1932x1910: 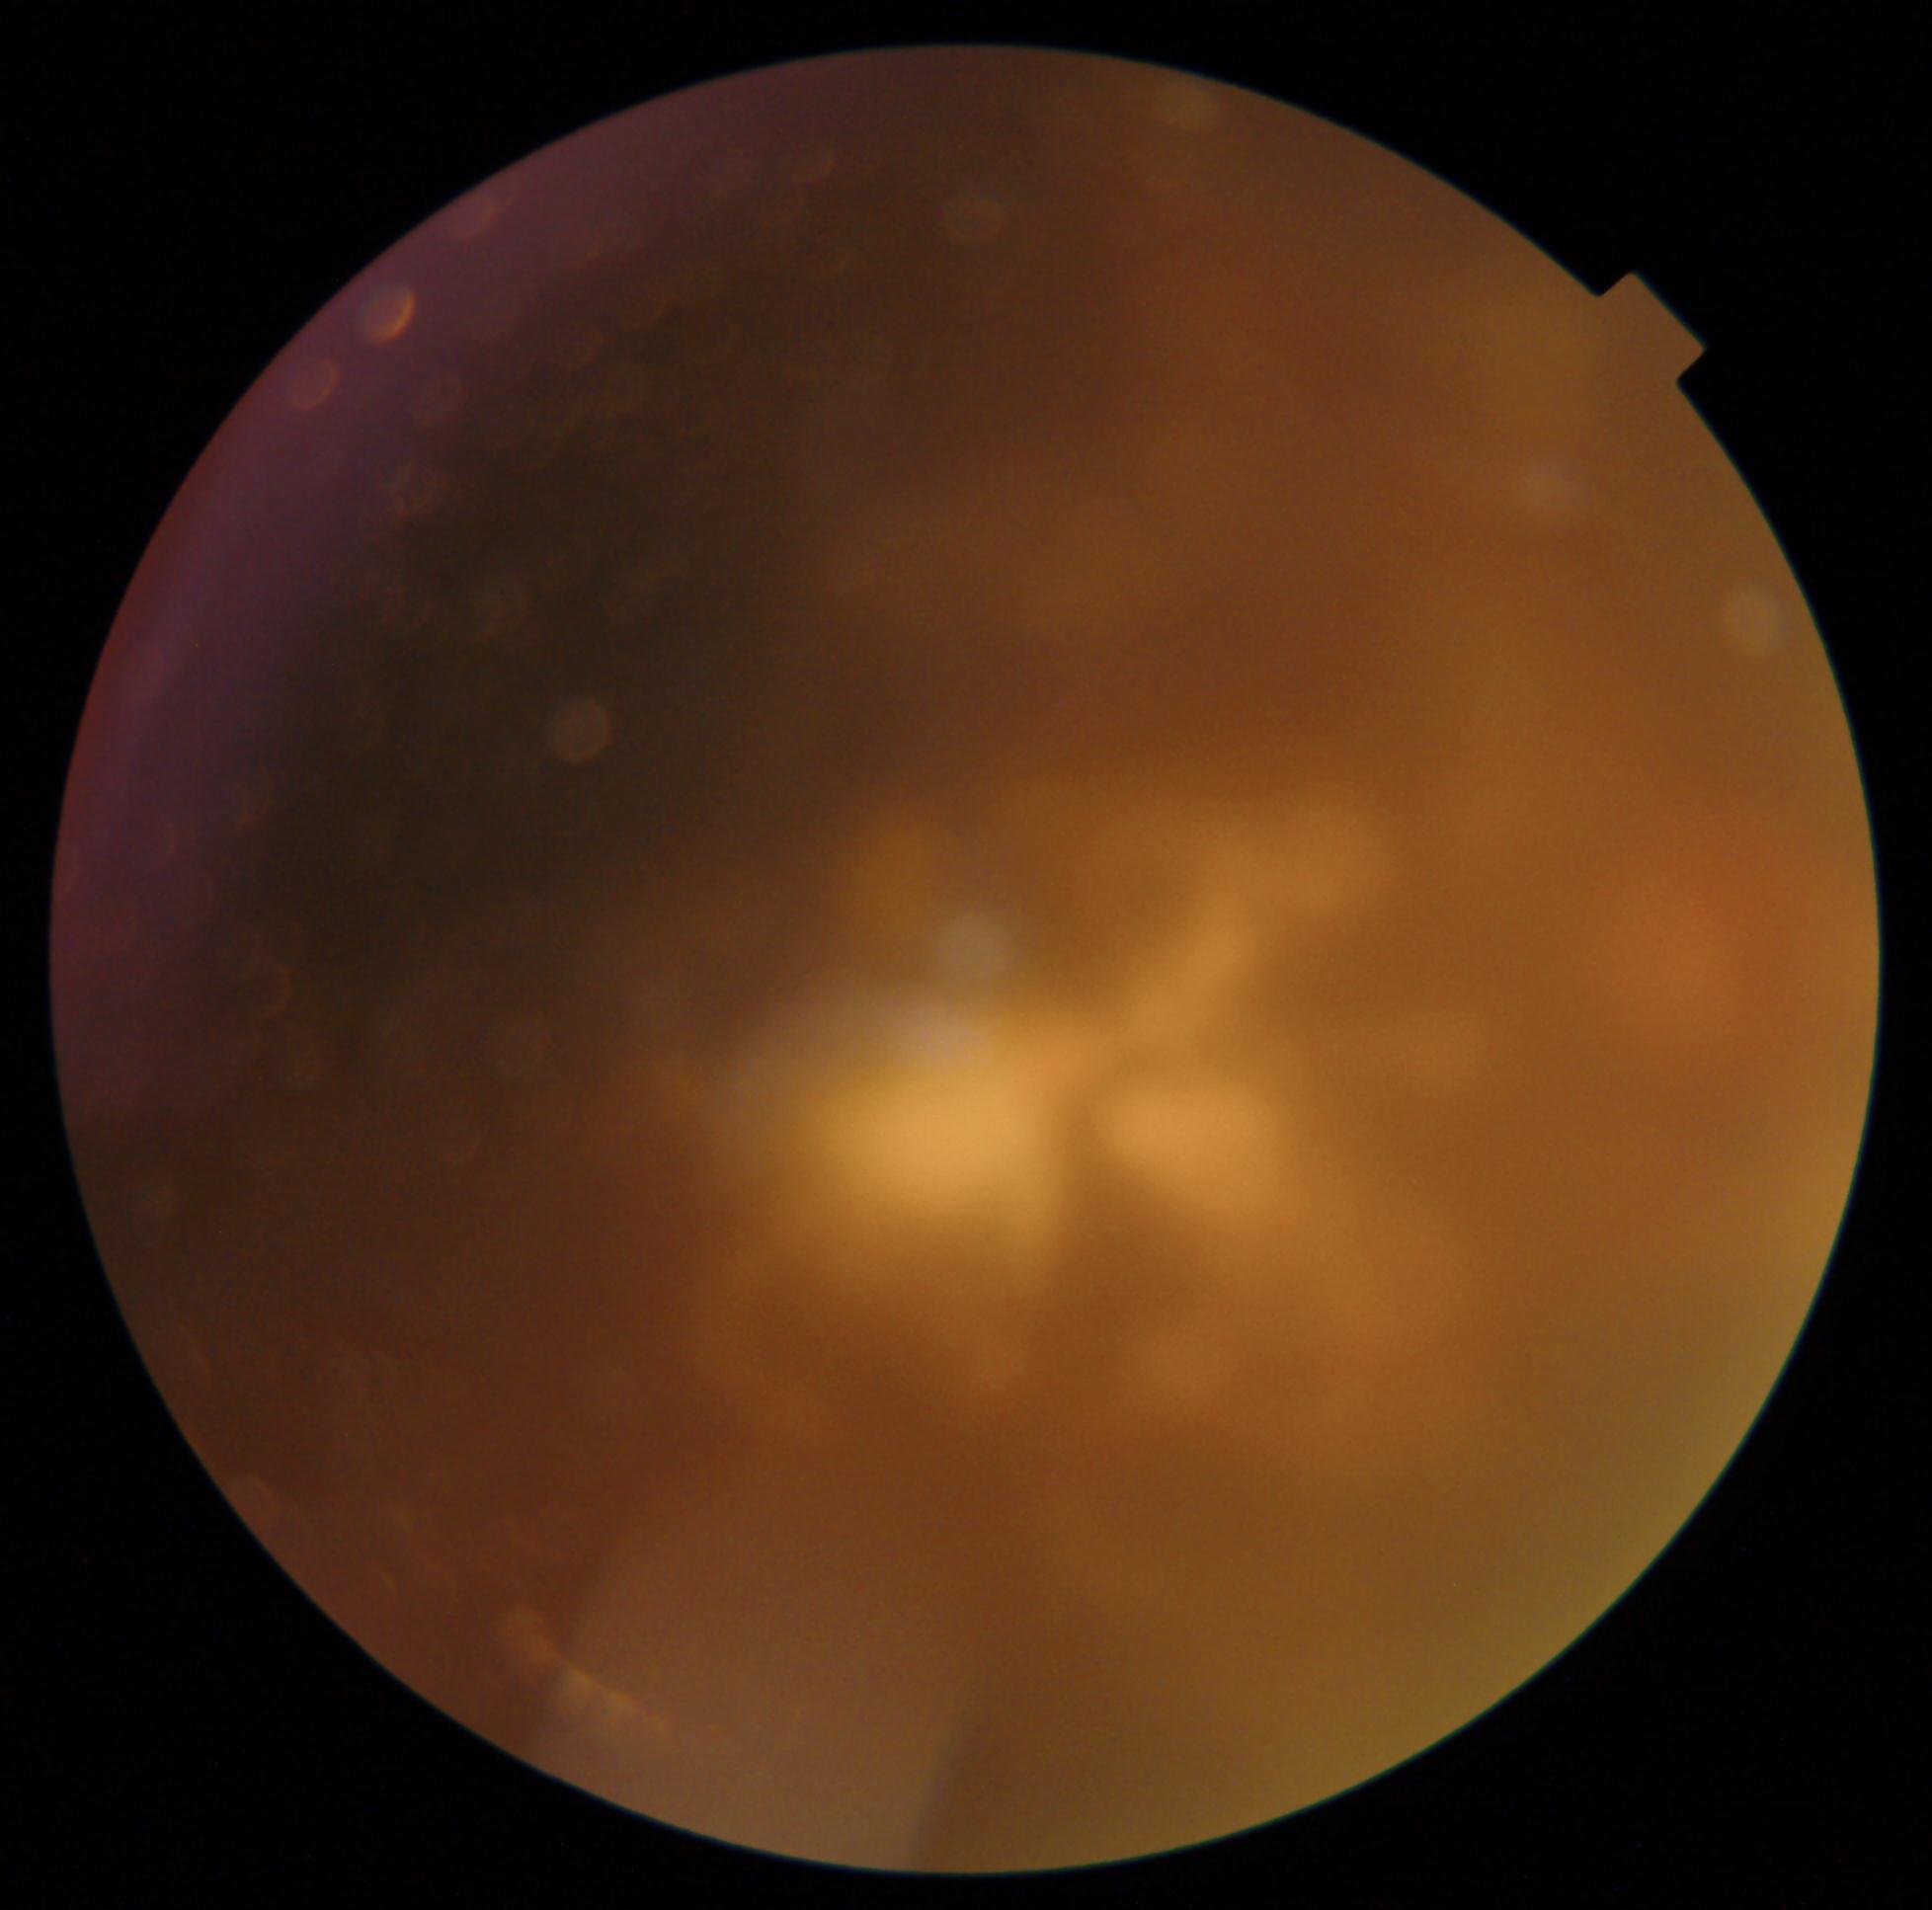 dr_grade: ungradable due to poor image quality